45 degree fundus photograph
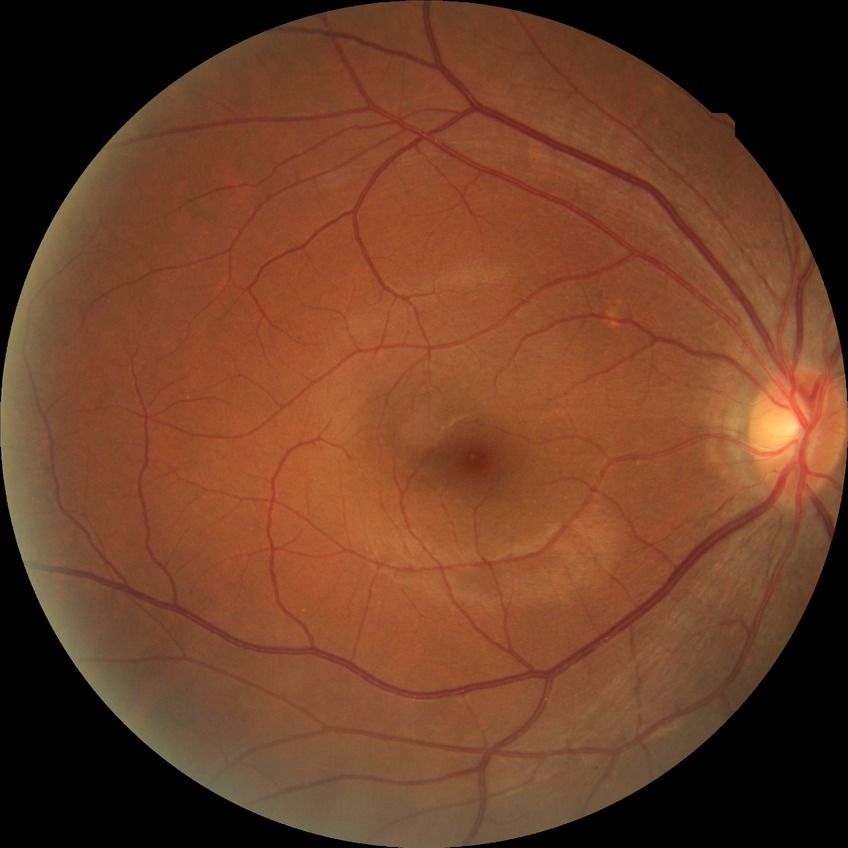
Diabetic retinopathy severity: no diabetic retinopathy.